Wide-field contact fundus photograph of an infant. Clarity RetCam 3, 130° FOV — 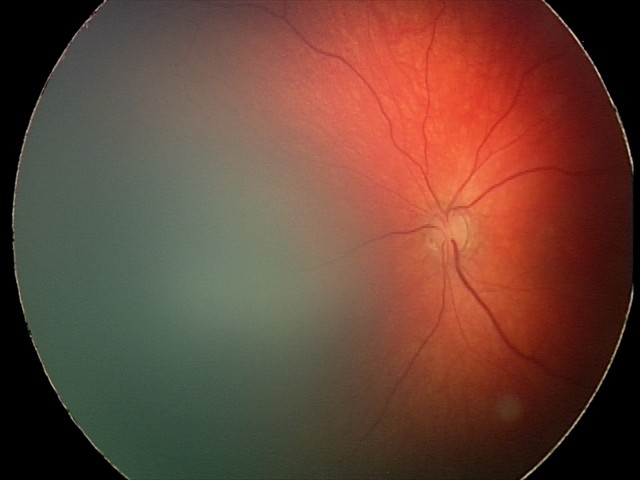
Q: What is the screening diagnosis?
A: retinal hemorrhages